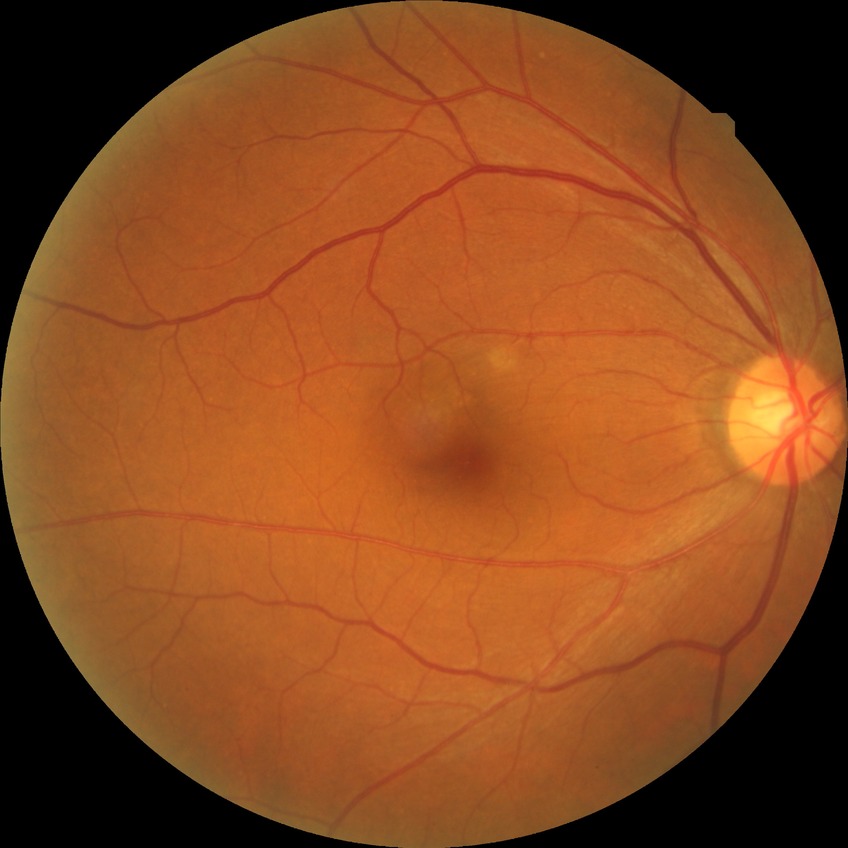

retinopathy stage: no diabetic retinopathy.